DR severity per modified Davis staging:
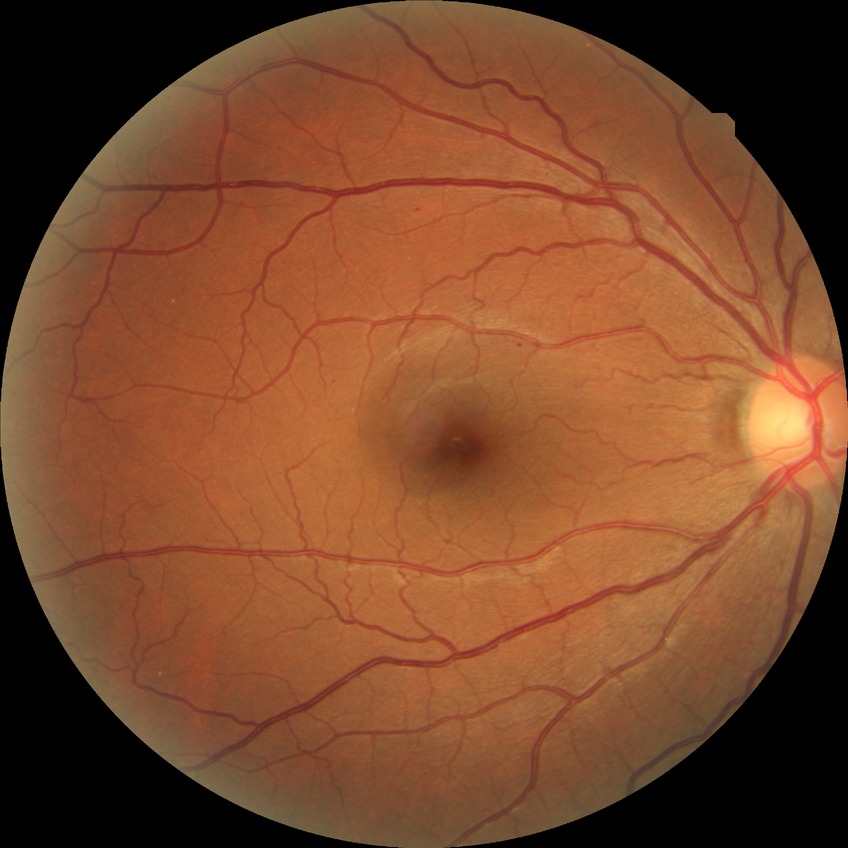
DR severity: SDR.